Color fundus image · 1624x1232px · 45° field of view
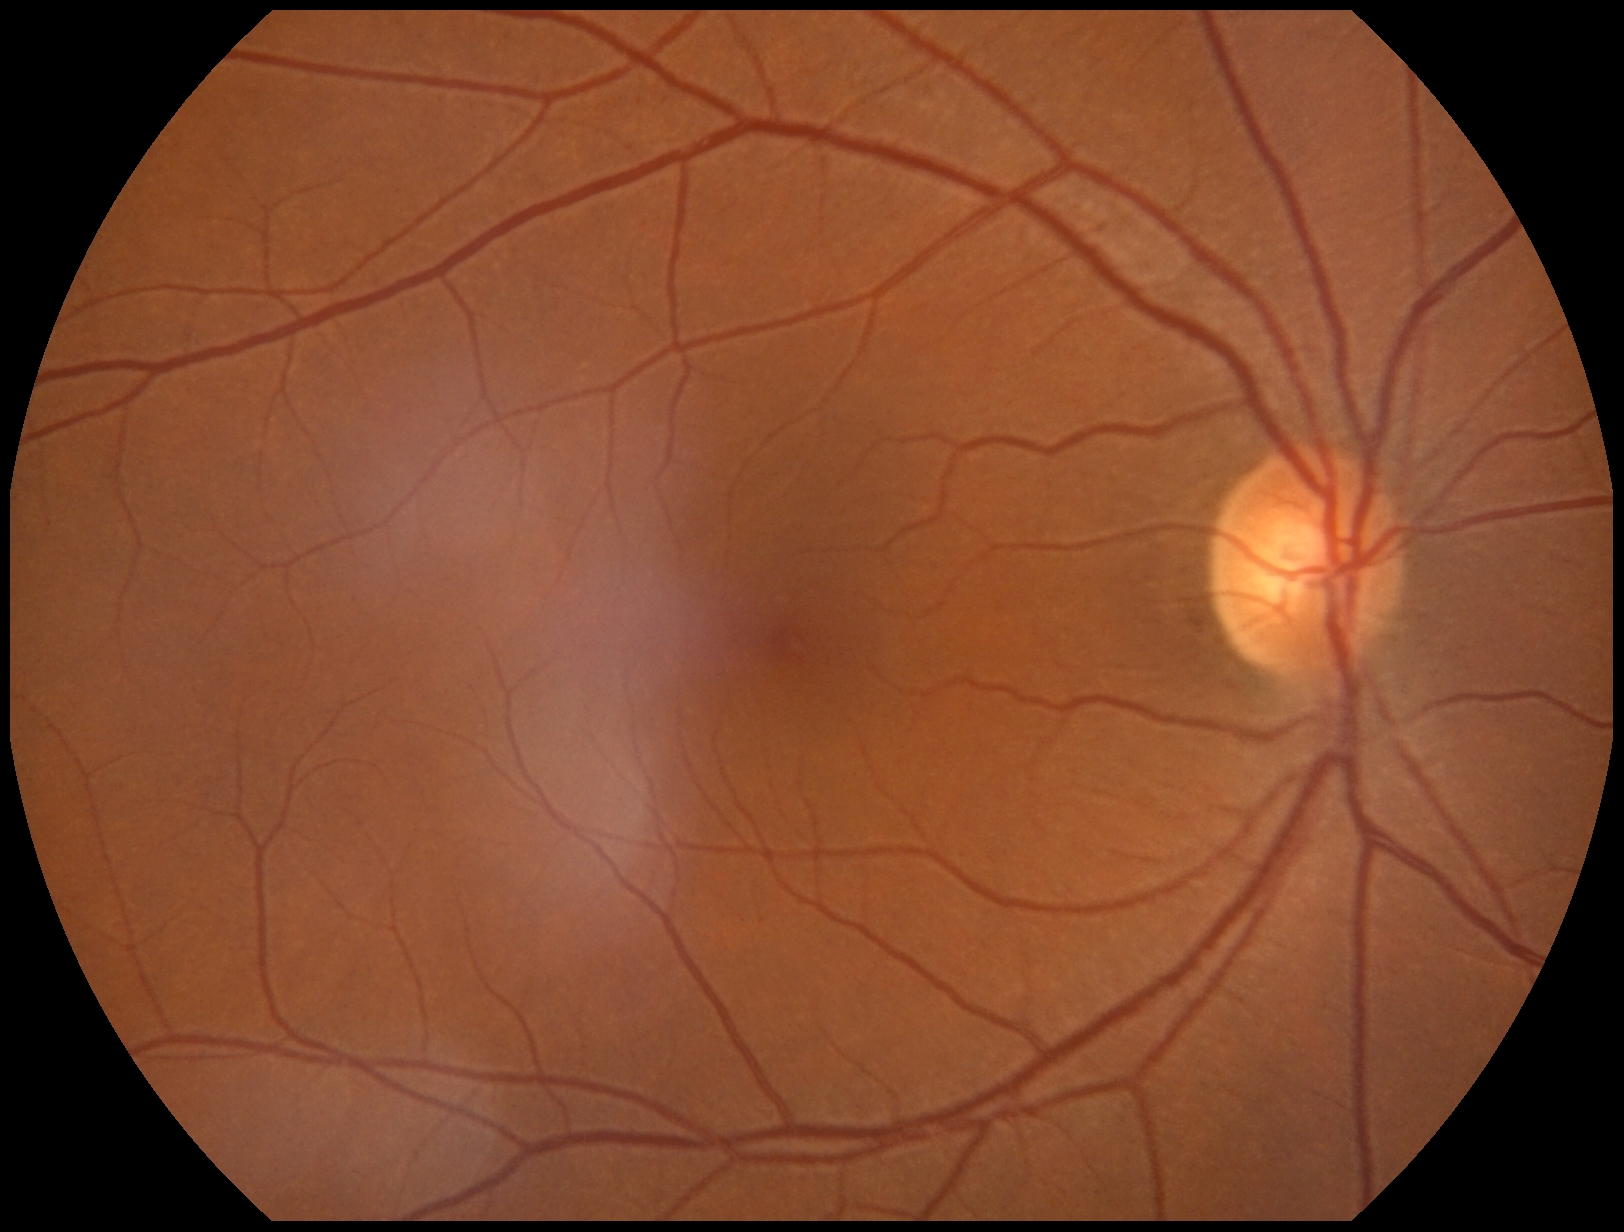

retinopathy grade@0.